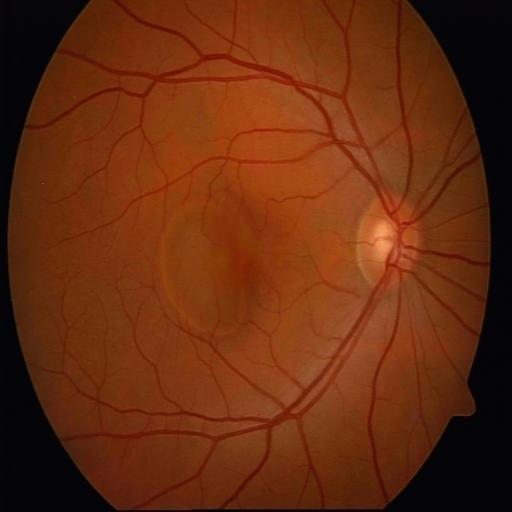
Impression: central serous retinopathy.